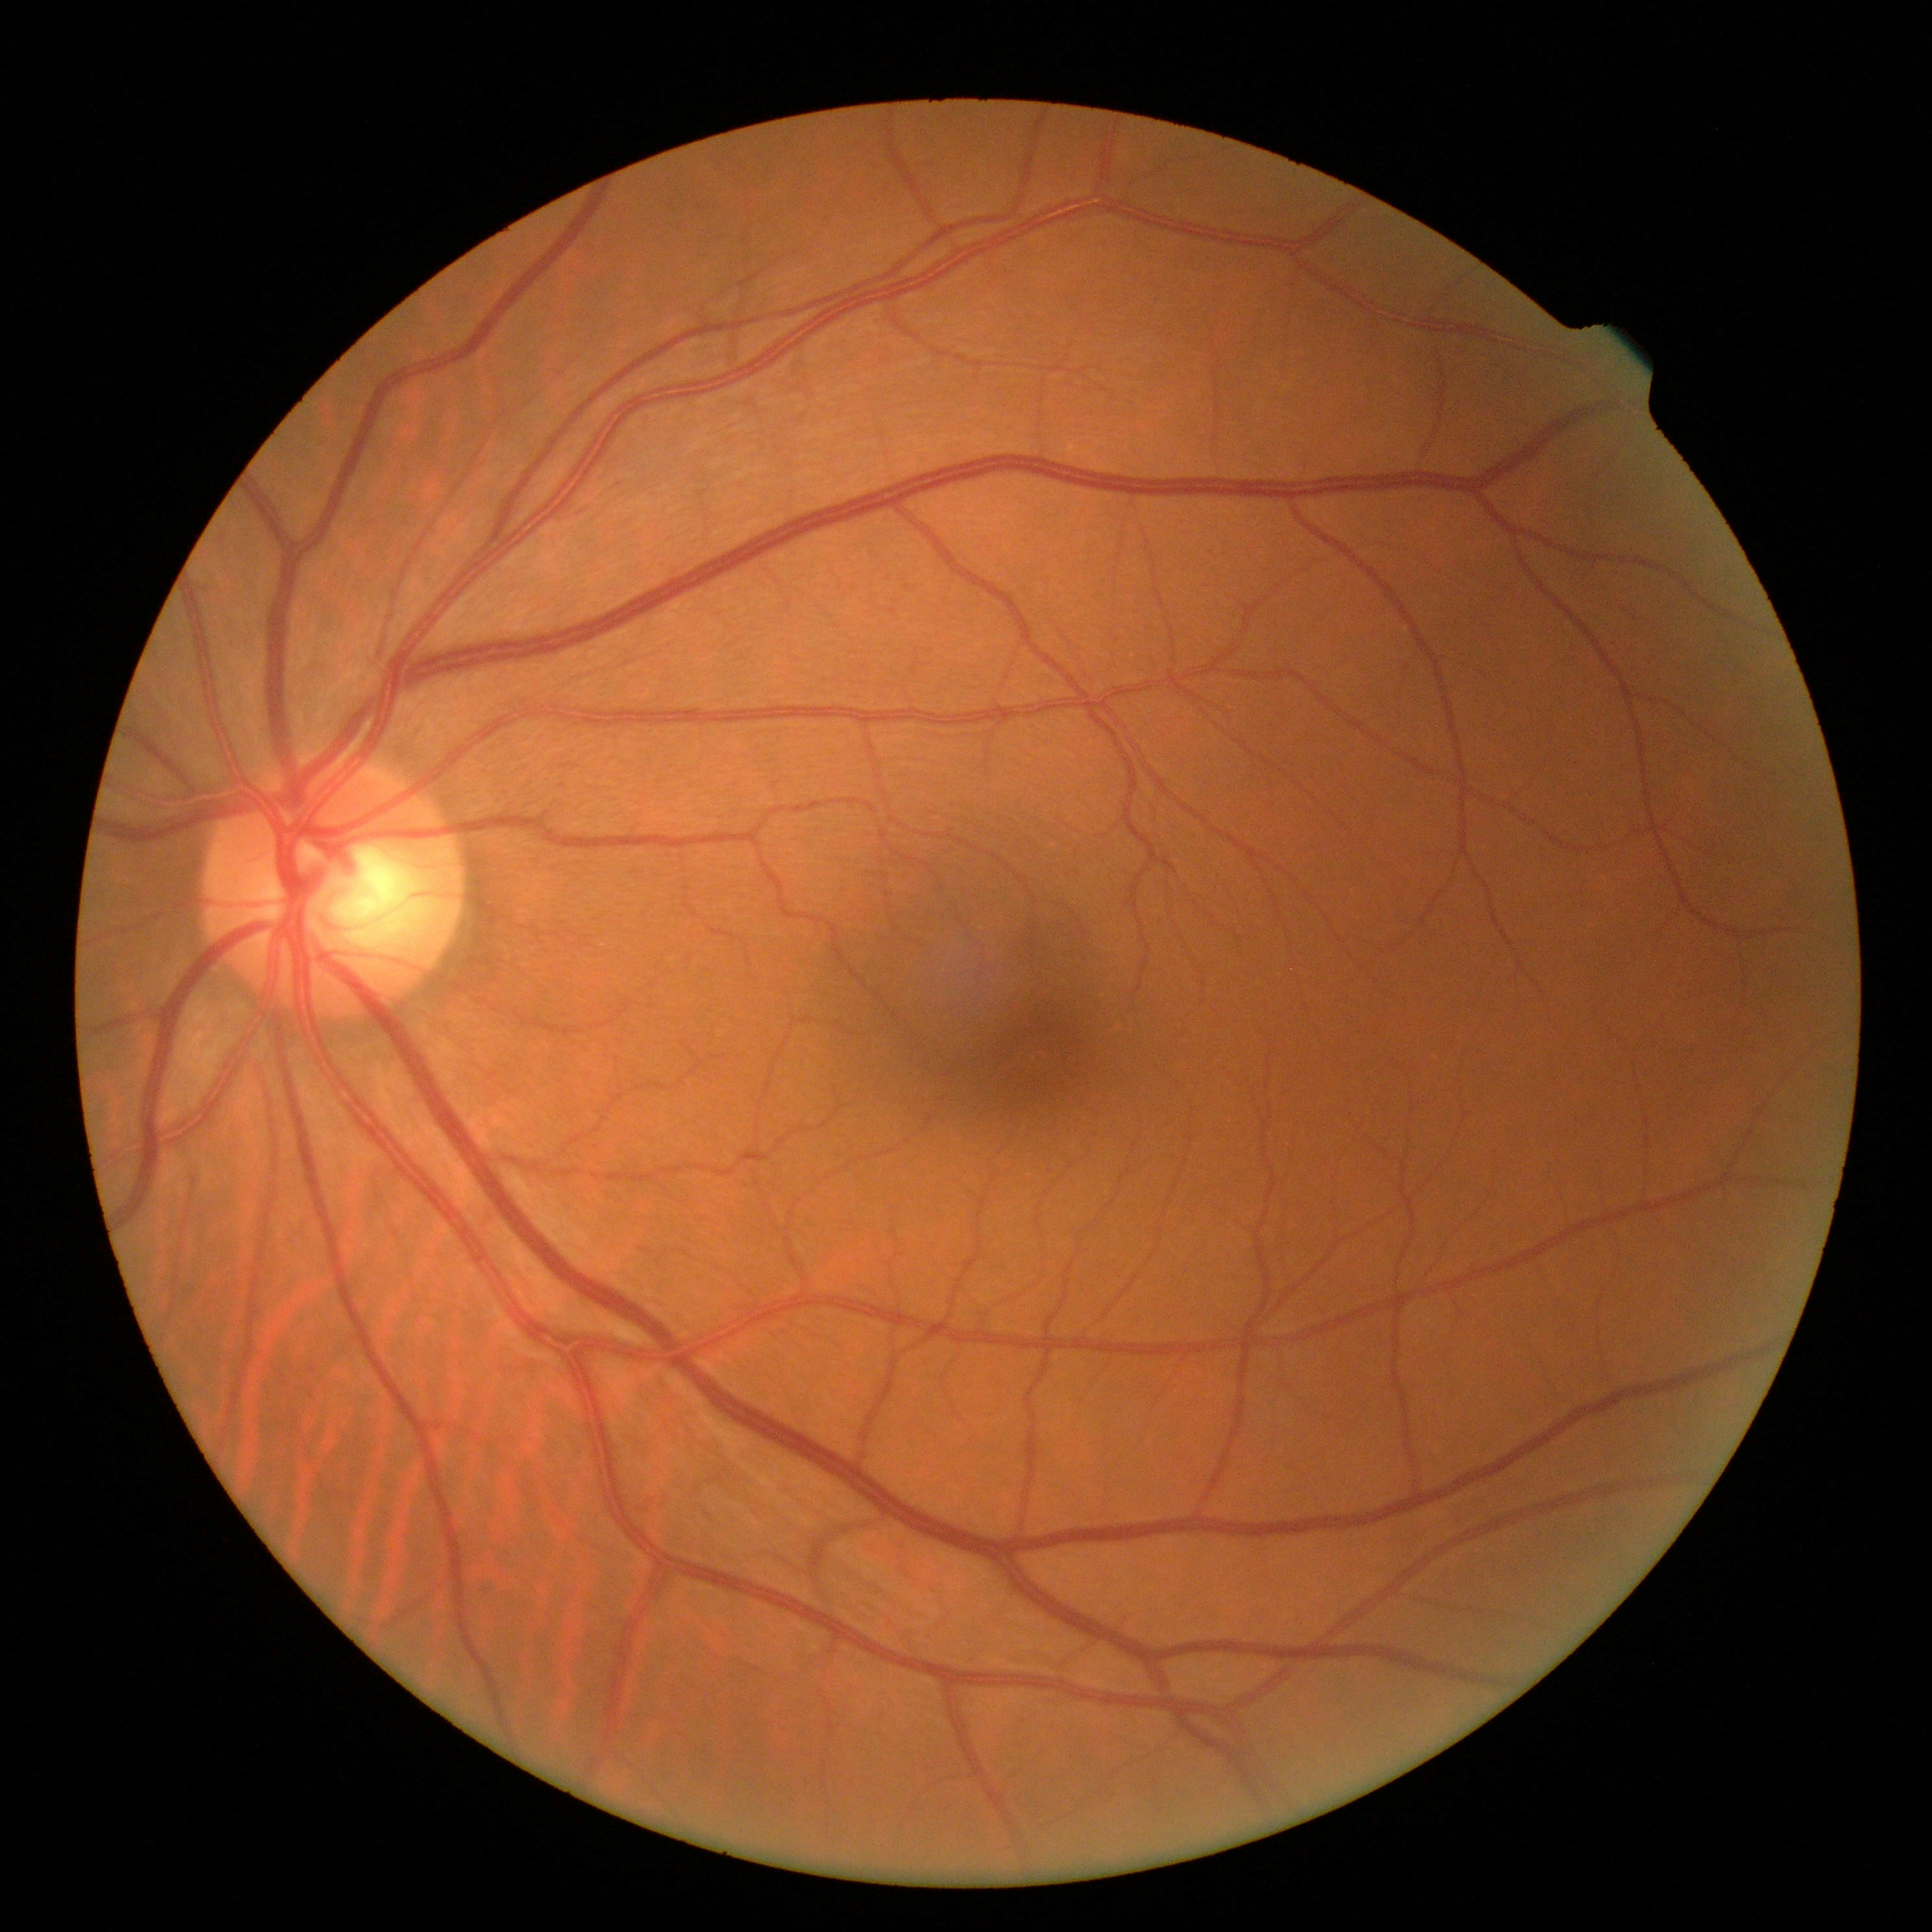 DR impression = no DR findings | diabetic retinopathy severity = no apparent diabetic retinopathy (grade 0).